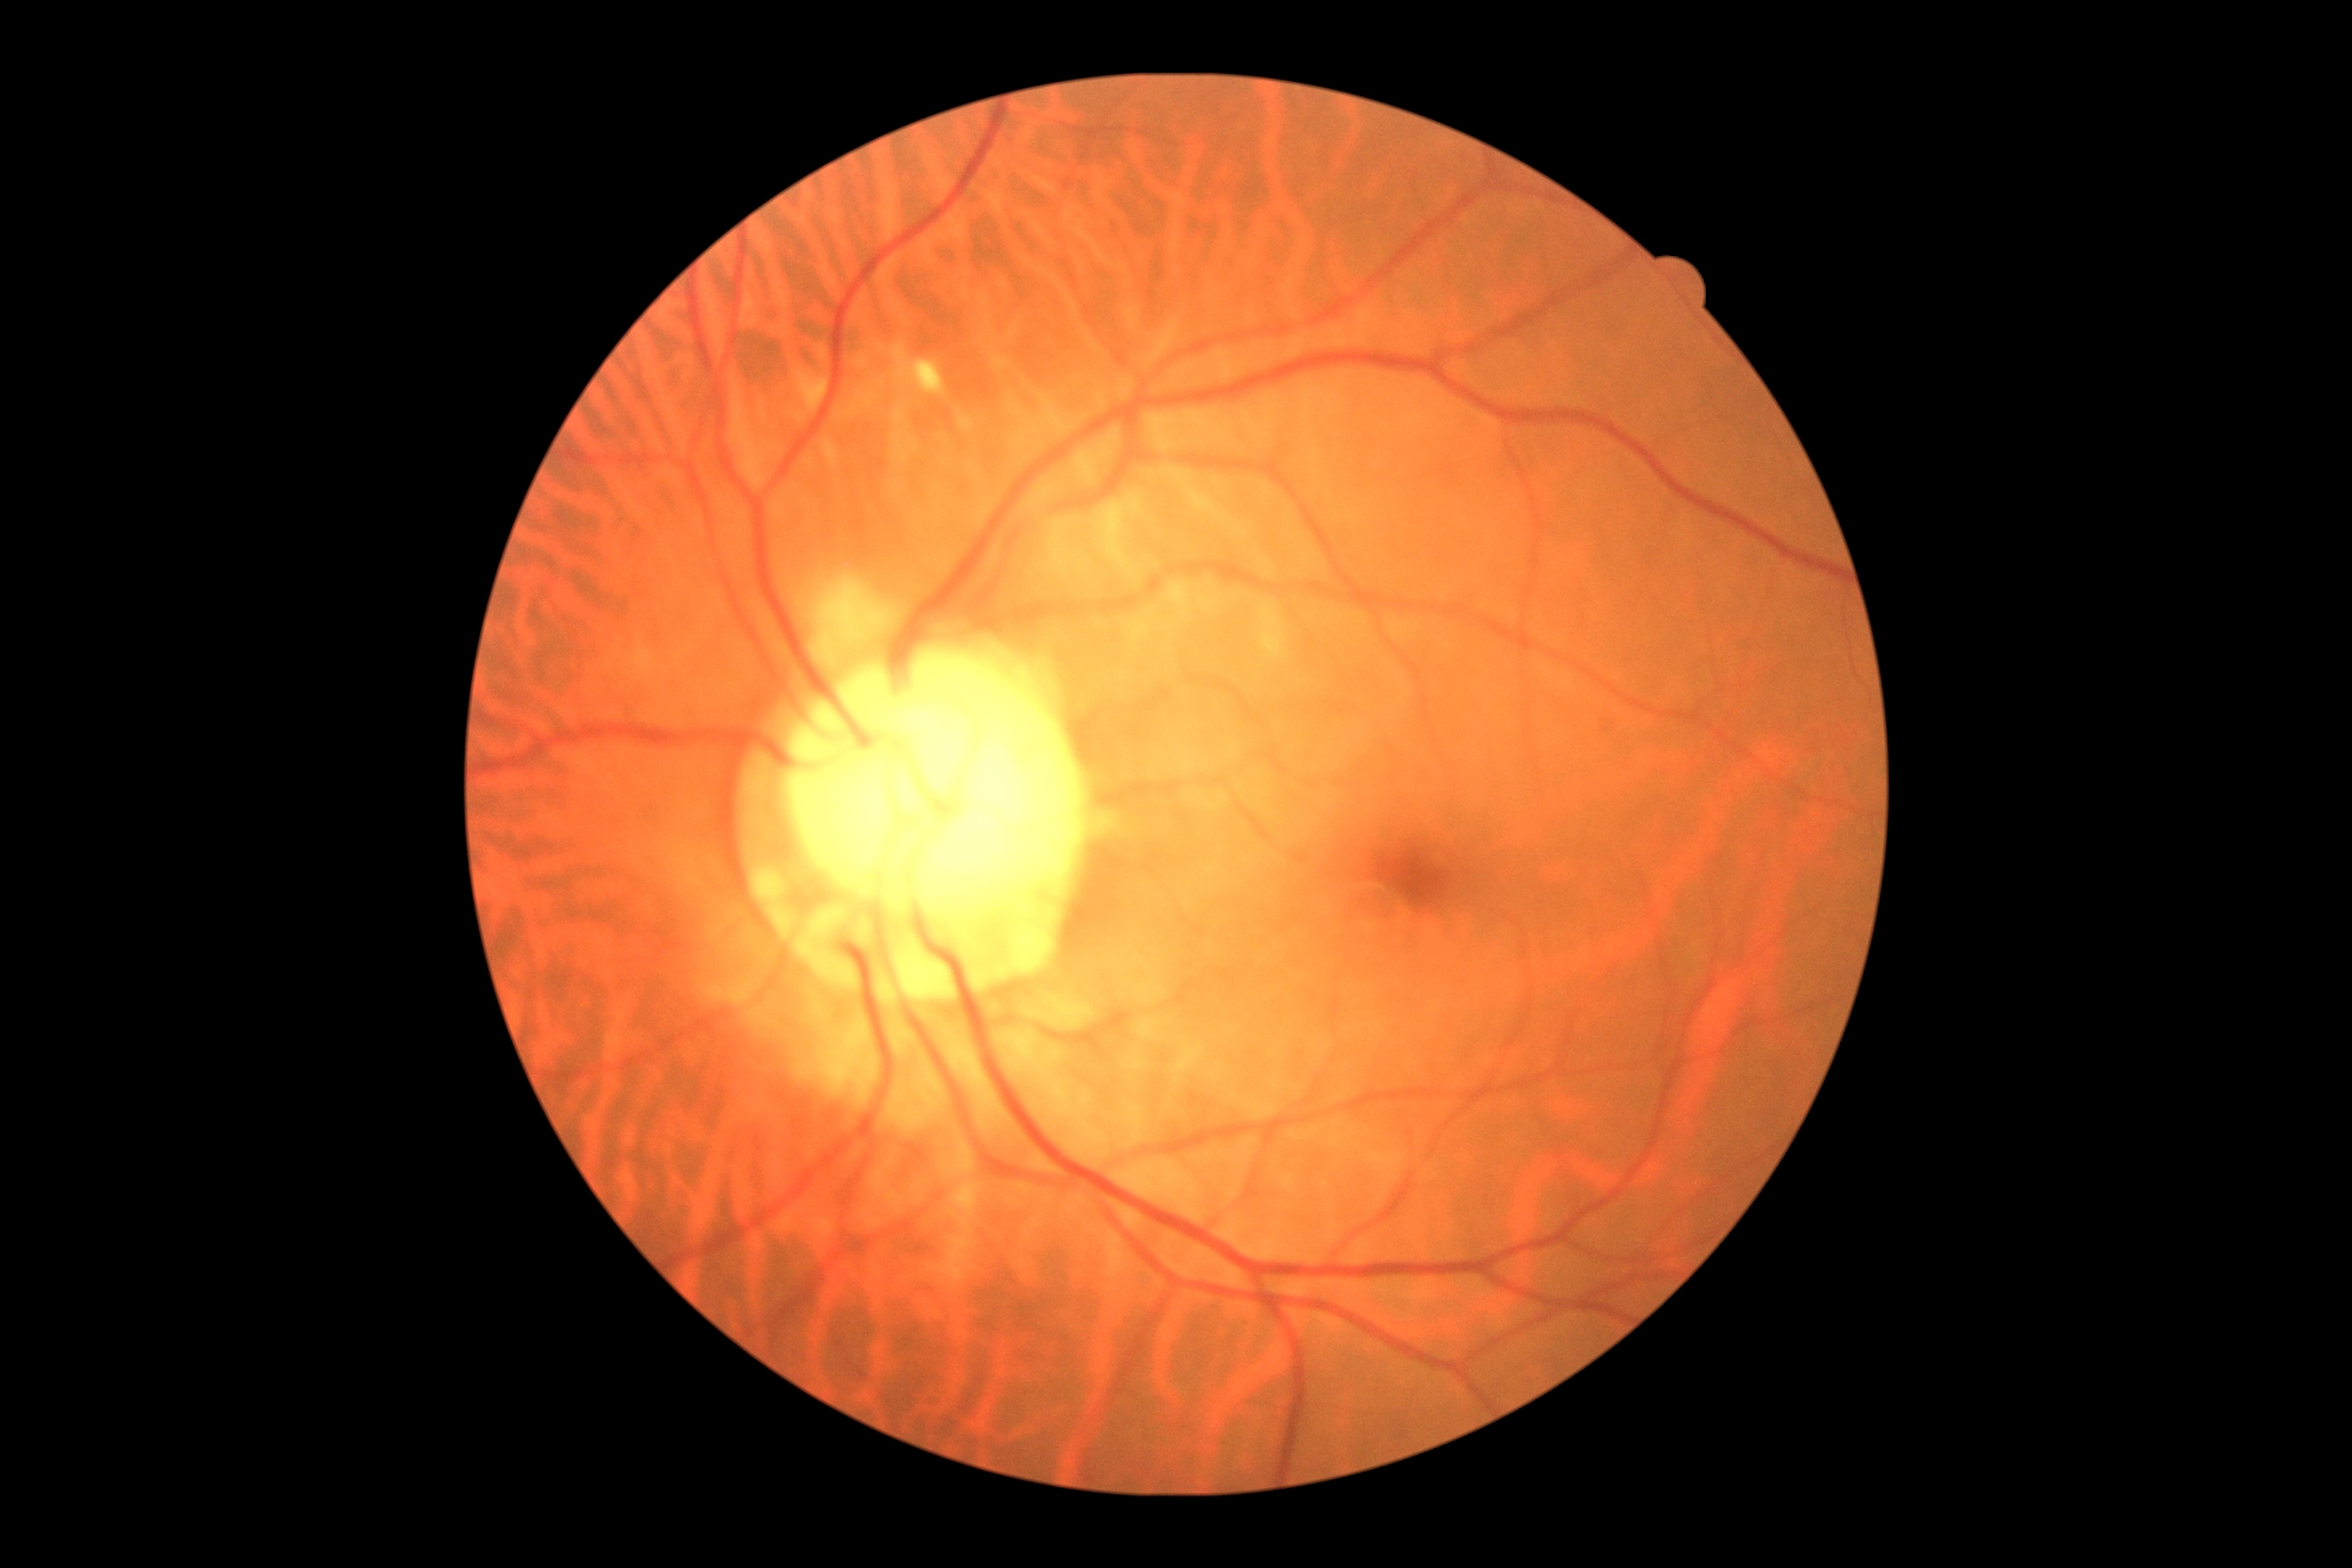

DR stage: no apparent retinopathy (grade 0). No DR findings.